Captured on a Remidio FOP fundus camera; fundus photo:
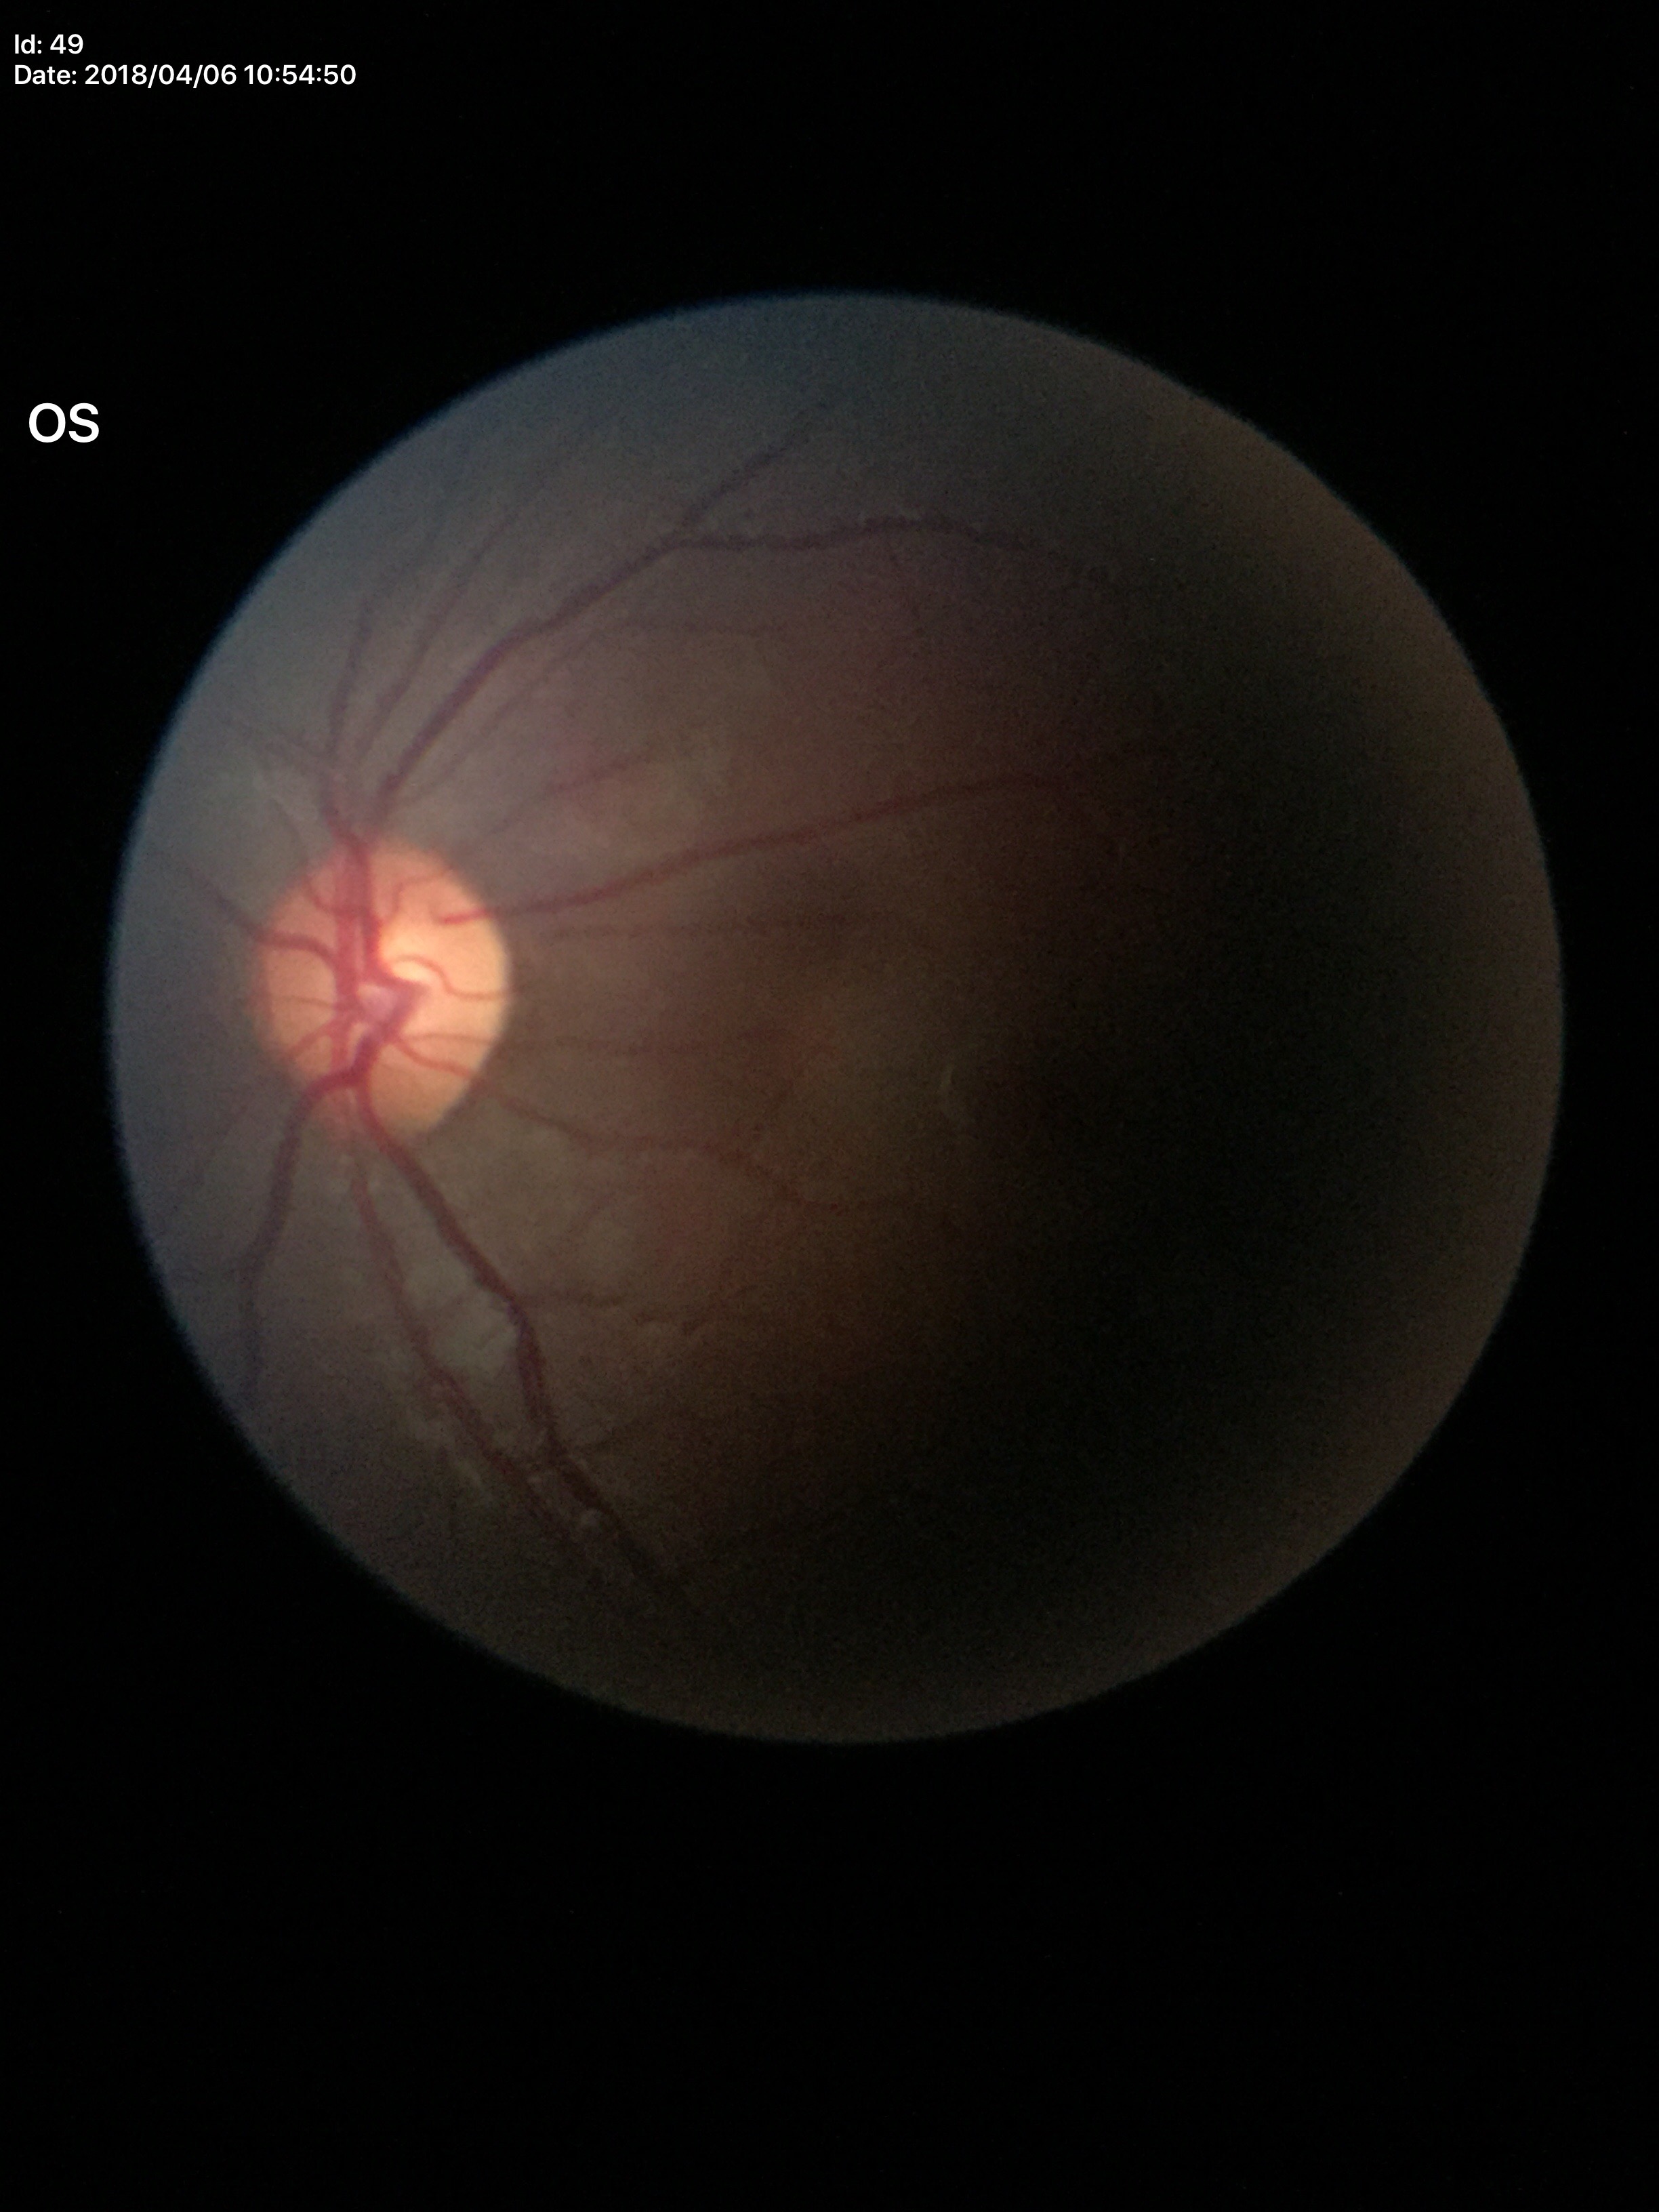
Glaucoma assessment = negative
vertical cup-to-disc ratio (VCDR) = 0.49